45° field of view, color fundus photograph: 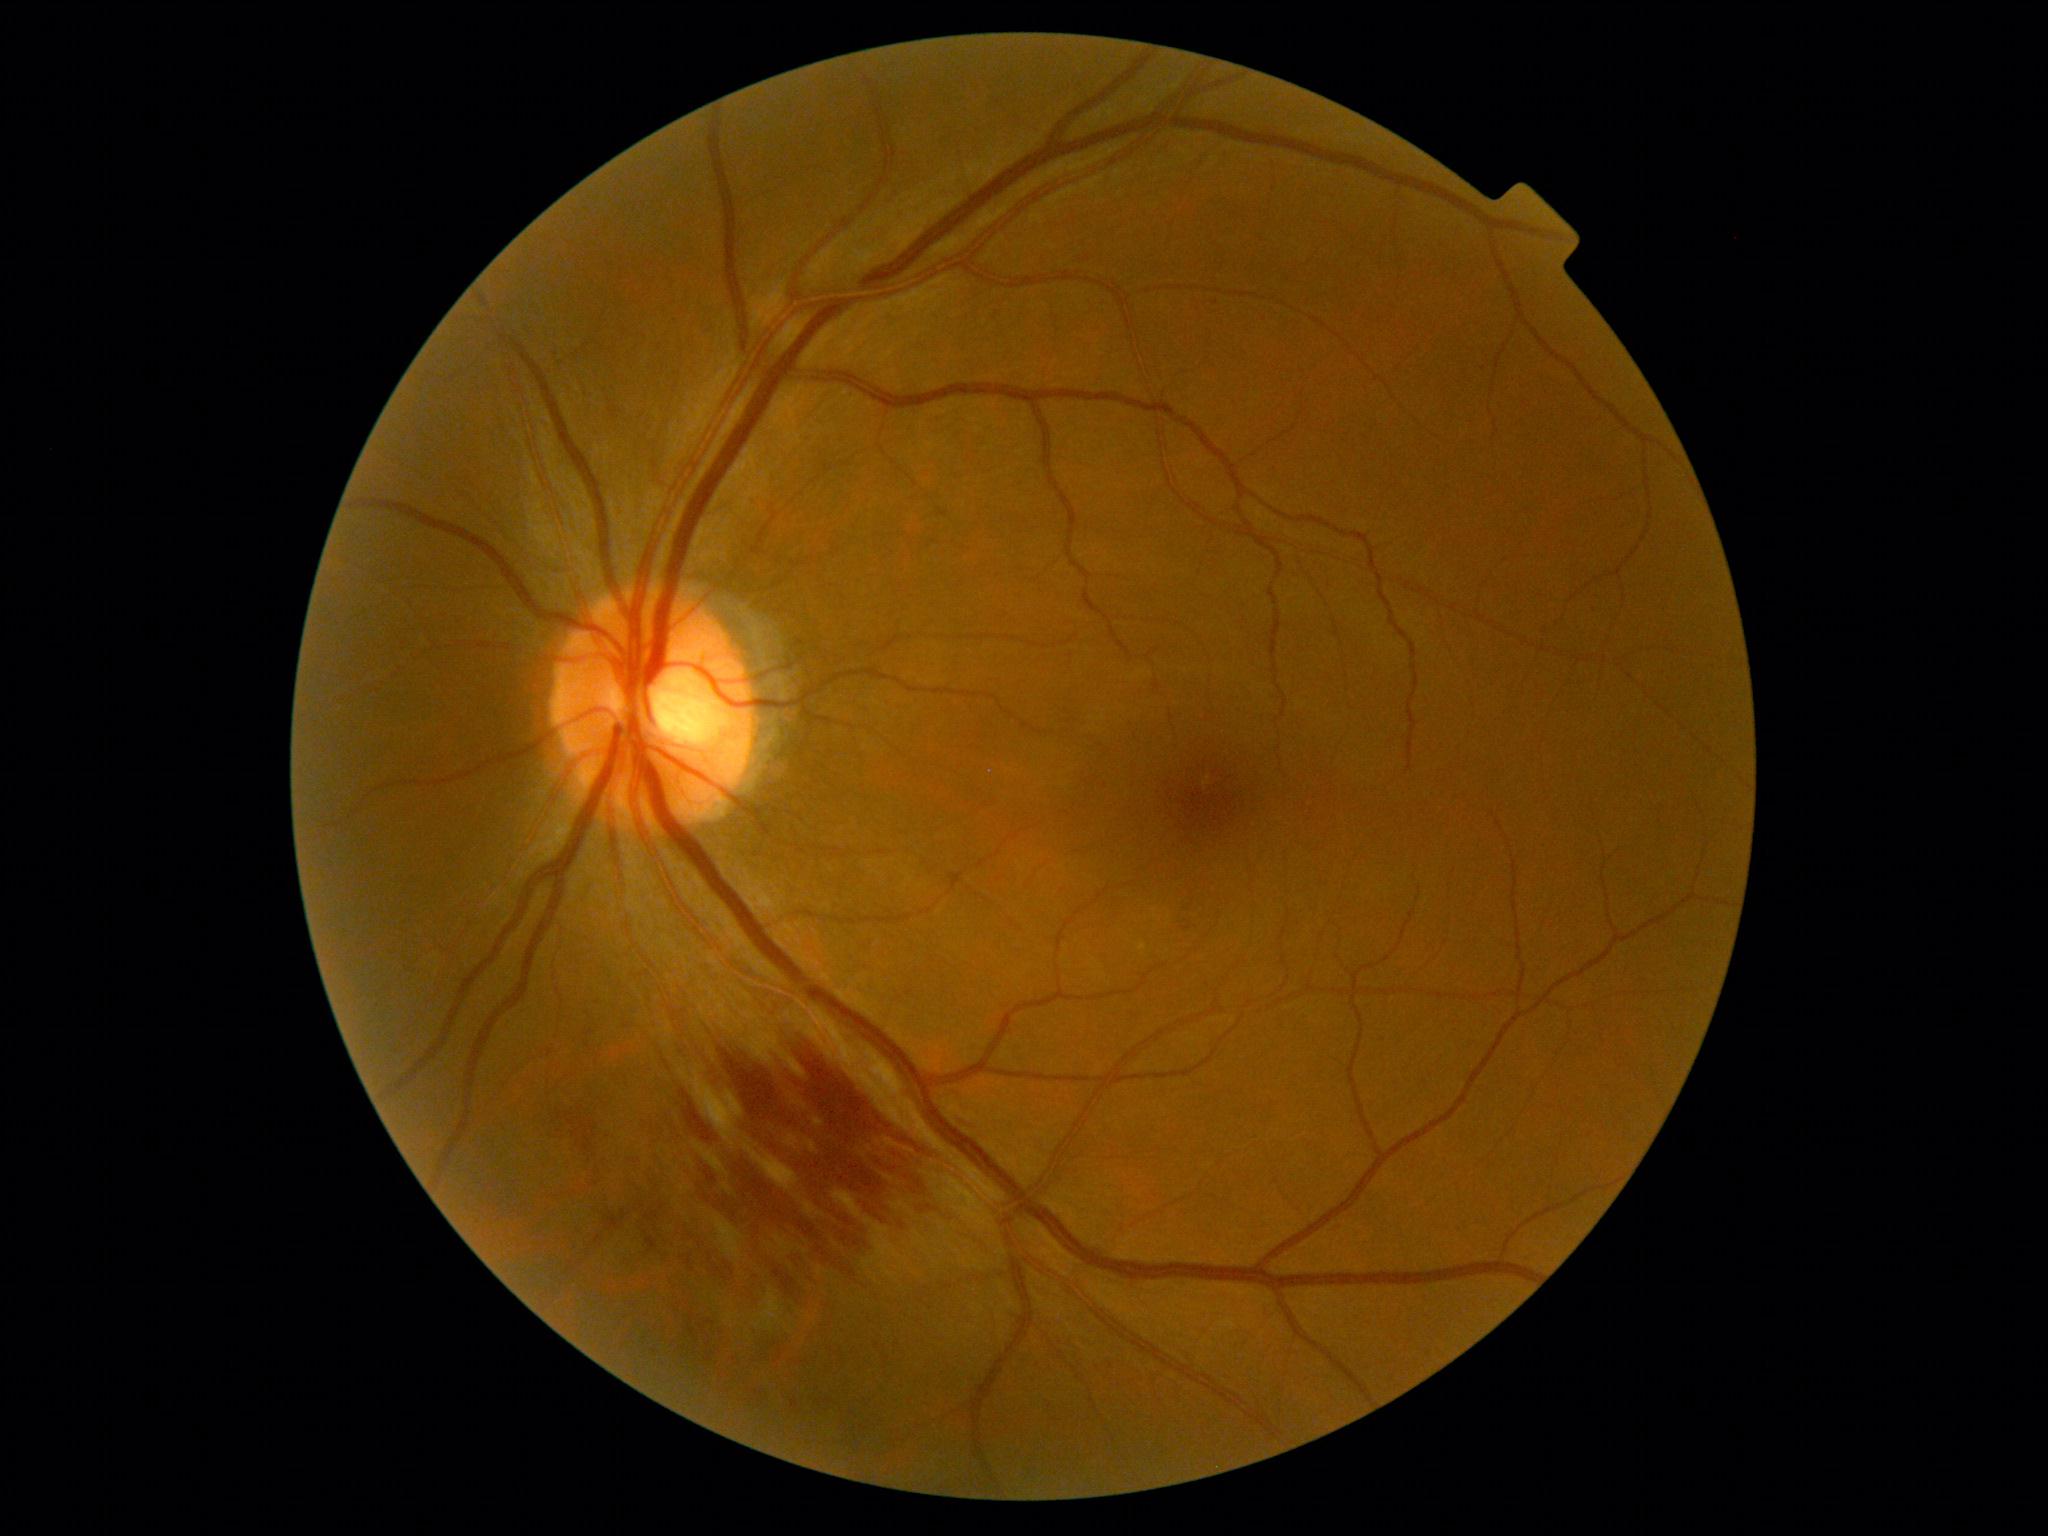
DR stage is moderate non-proliferative diabetic retinopathy (grade 2).